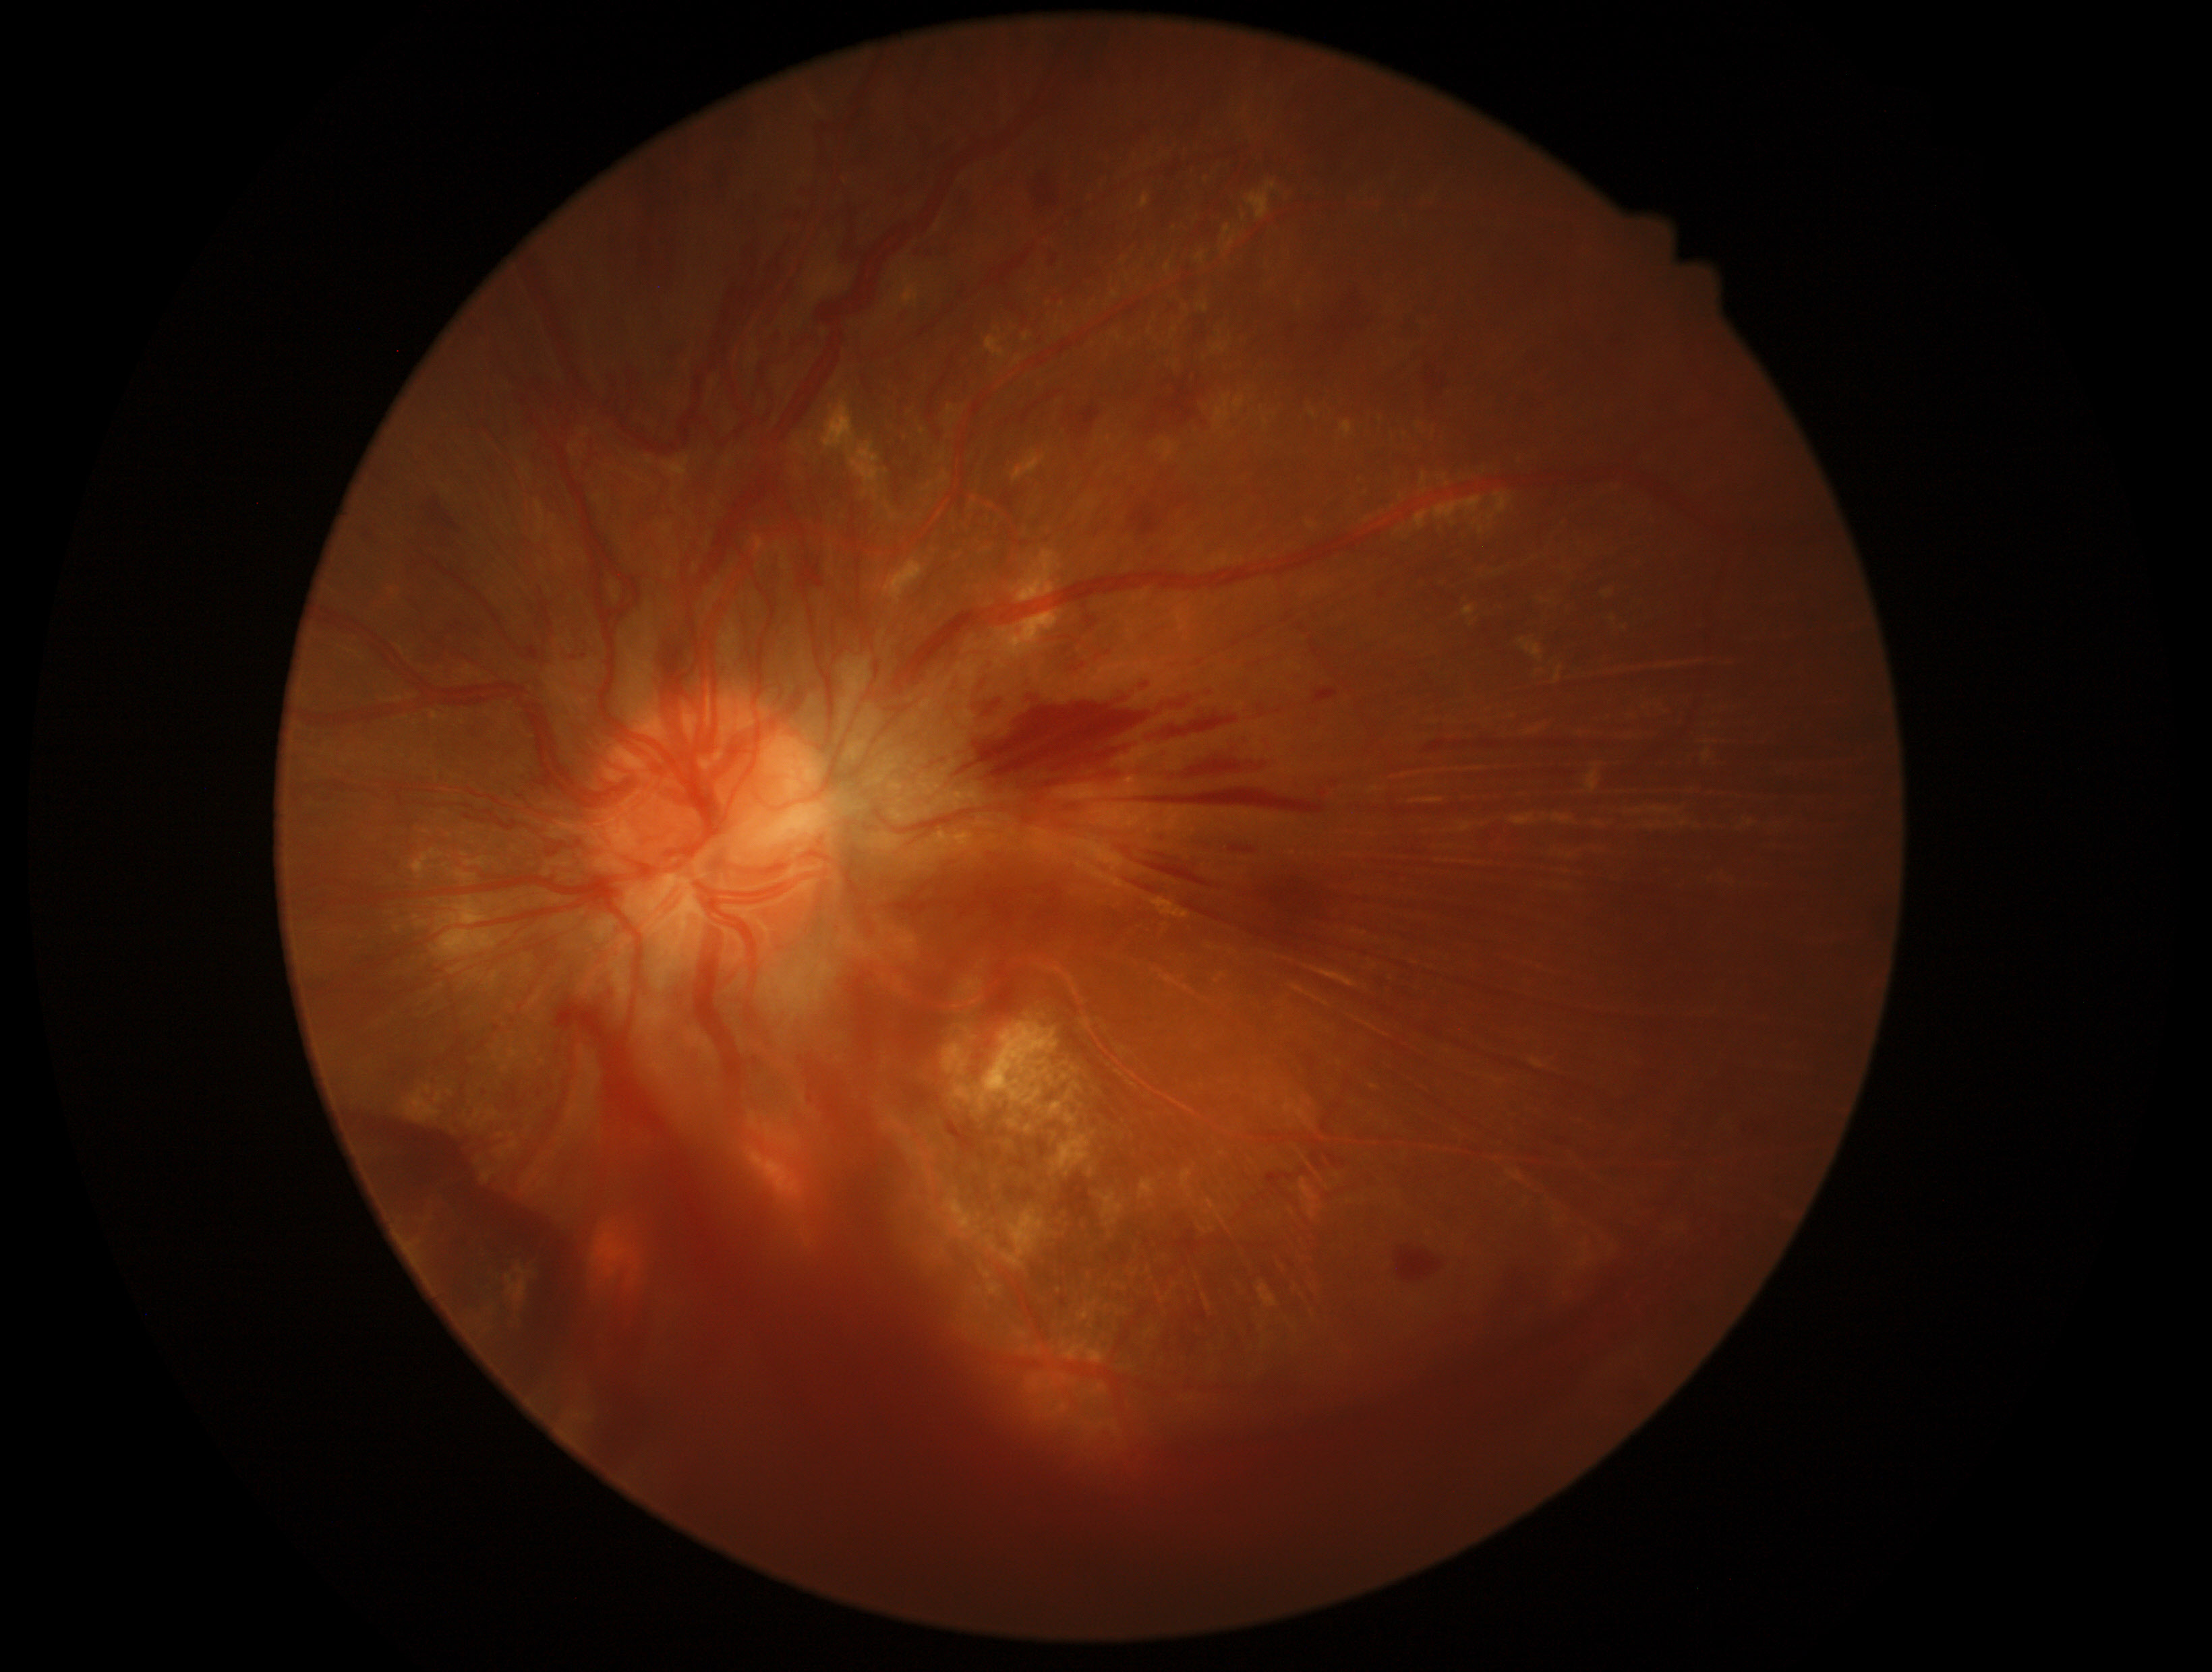 Retinopathy grade: 4.